1440x1080px · camera: Natus RetCam Envision (130° FOV) · infant wide-field retinal image
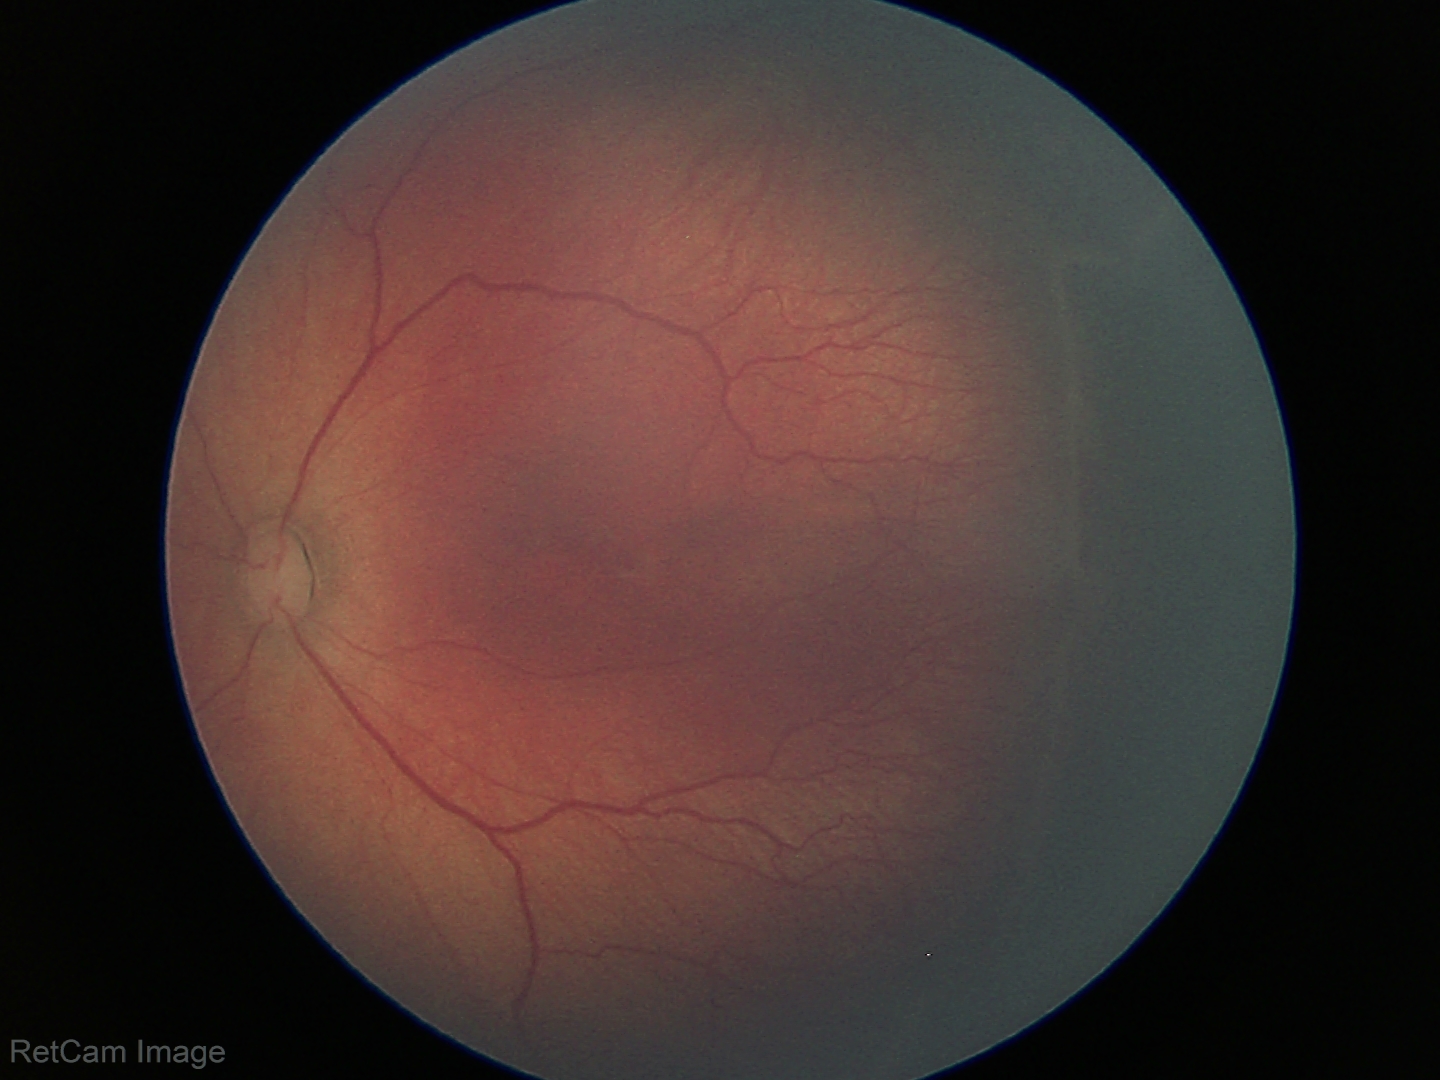
No plus disease.
Diagnosis from this screening exam: retinopathy of prematurity (ROP) stage 2.